848x848px; FOV: 45 degrees; no pharmacologic dilation; modified Davis grading; retinal fundus photograph
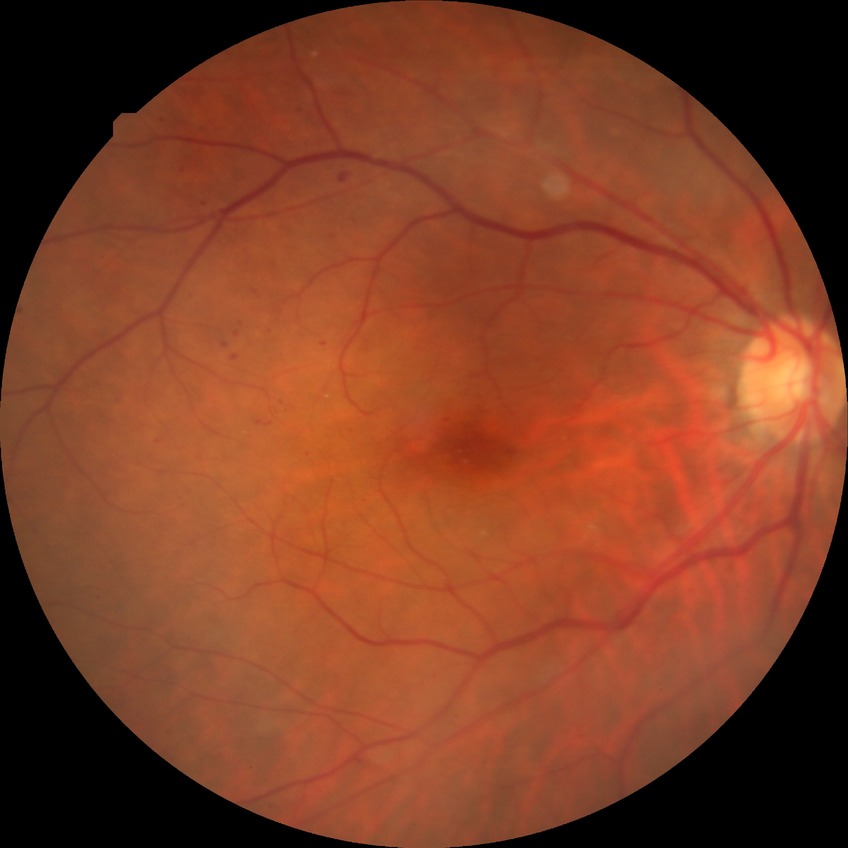

  davis_grade: simple diabetic retinopathy (SDR)